Infant wide-field retinal image. 1240x1240px.
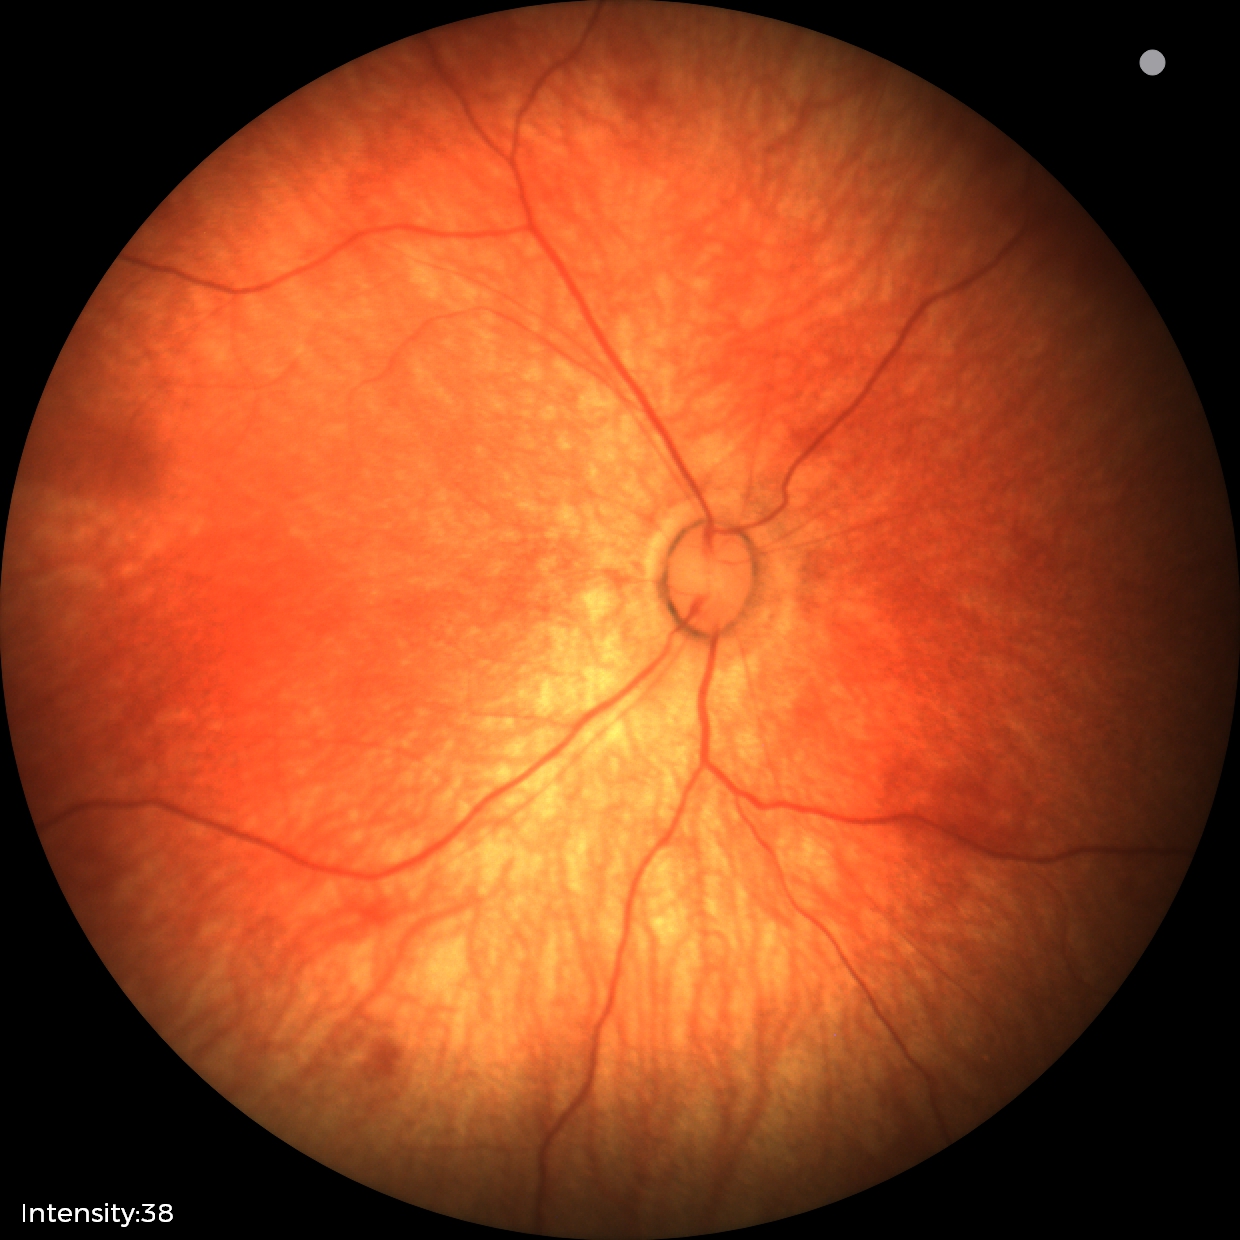
Normal screening examination.